Nonmydriatic; 45-degree field of view:
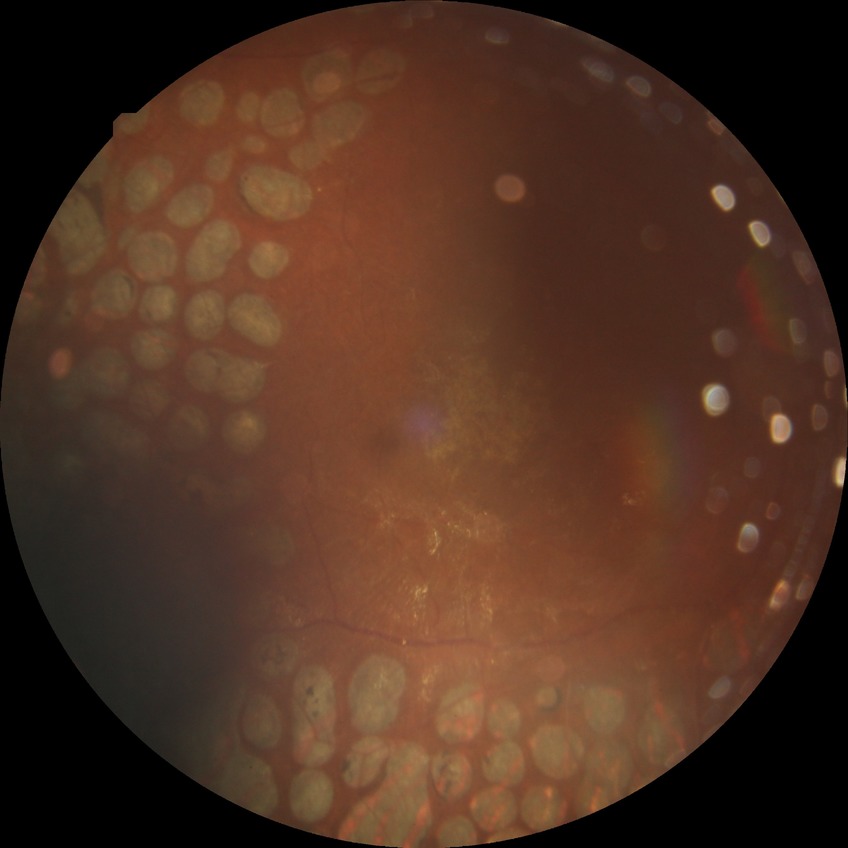
Davis grading: proliferative diabetic retinopathy.